Nonmydriatic fundus photograph. Camera: NIDEK AFC-230. 45 degree fundus photograph — 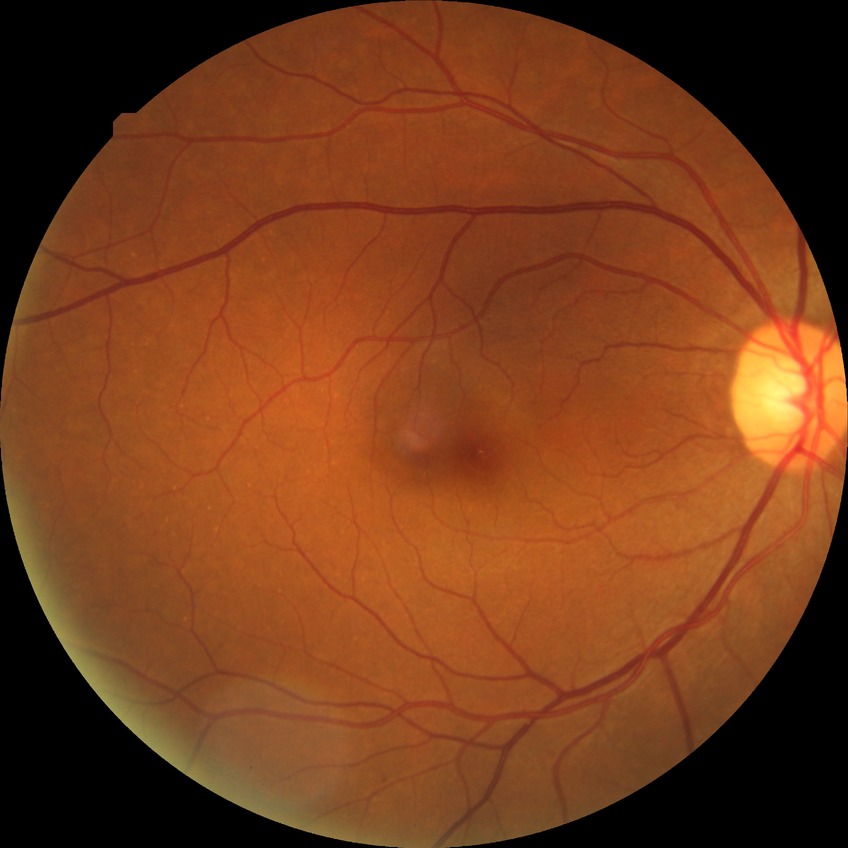

Diabetic retinopathy (DR) is SDR (simple diabetic retinopathy).